1932x1932.
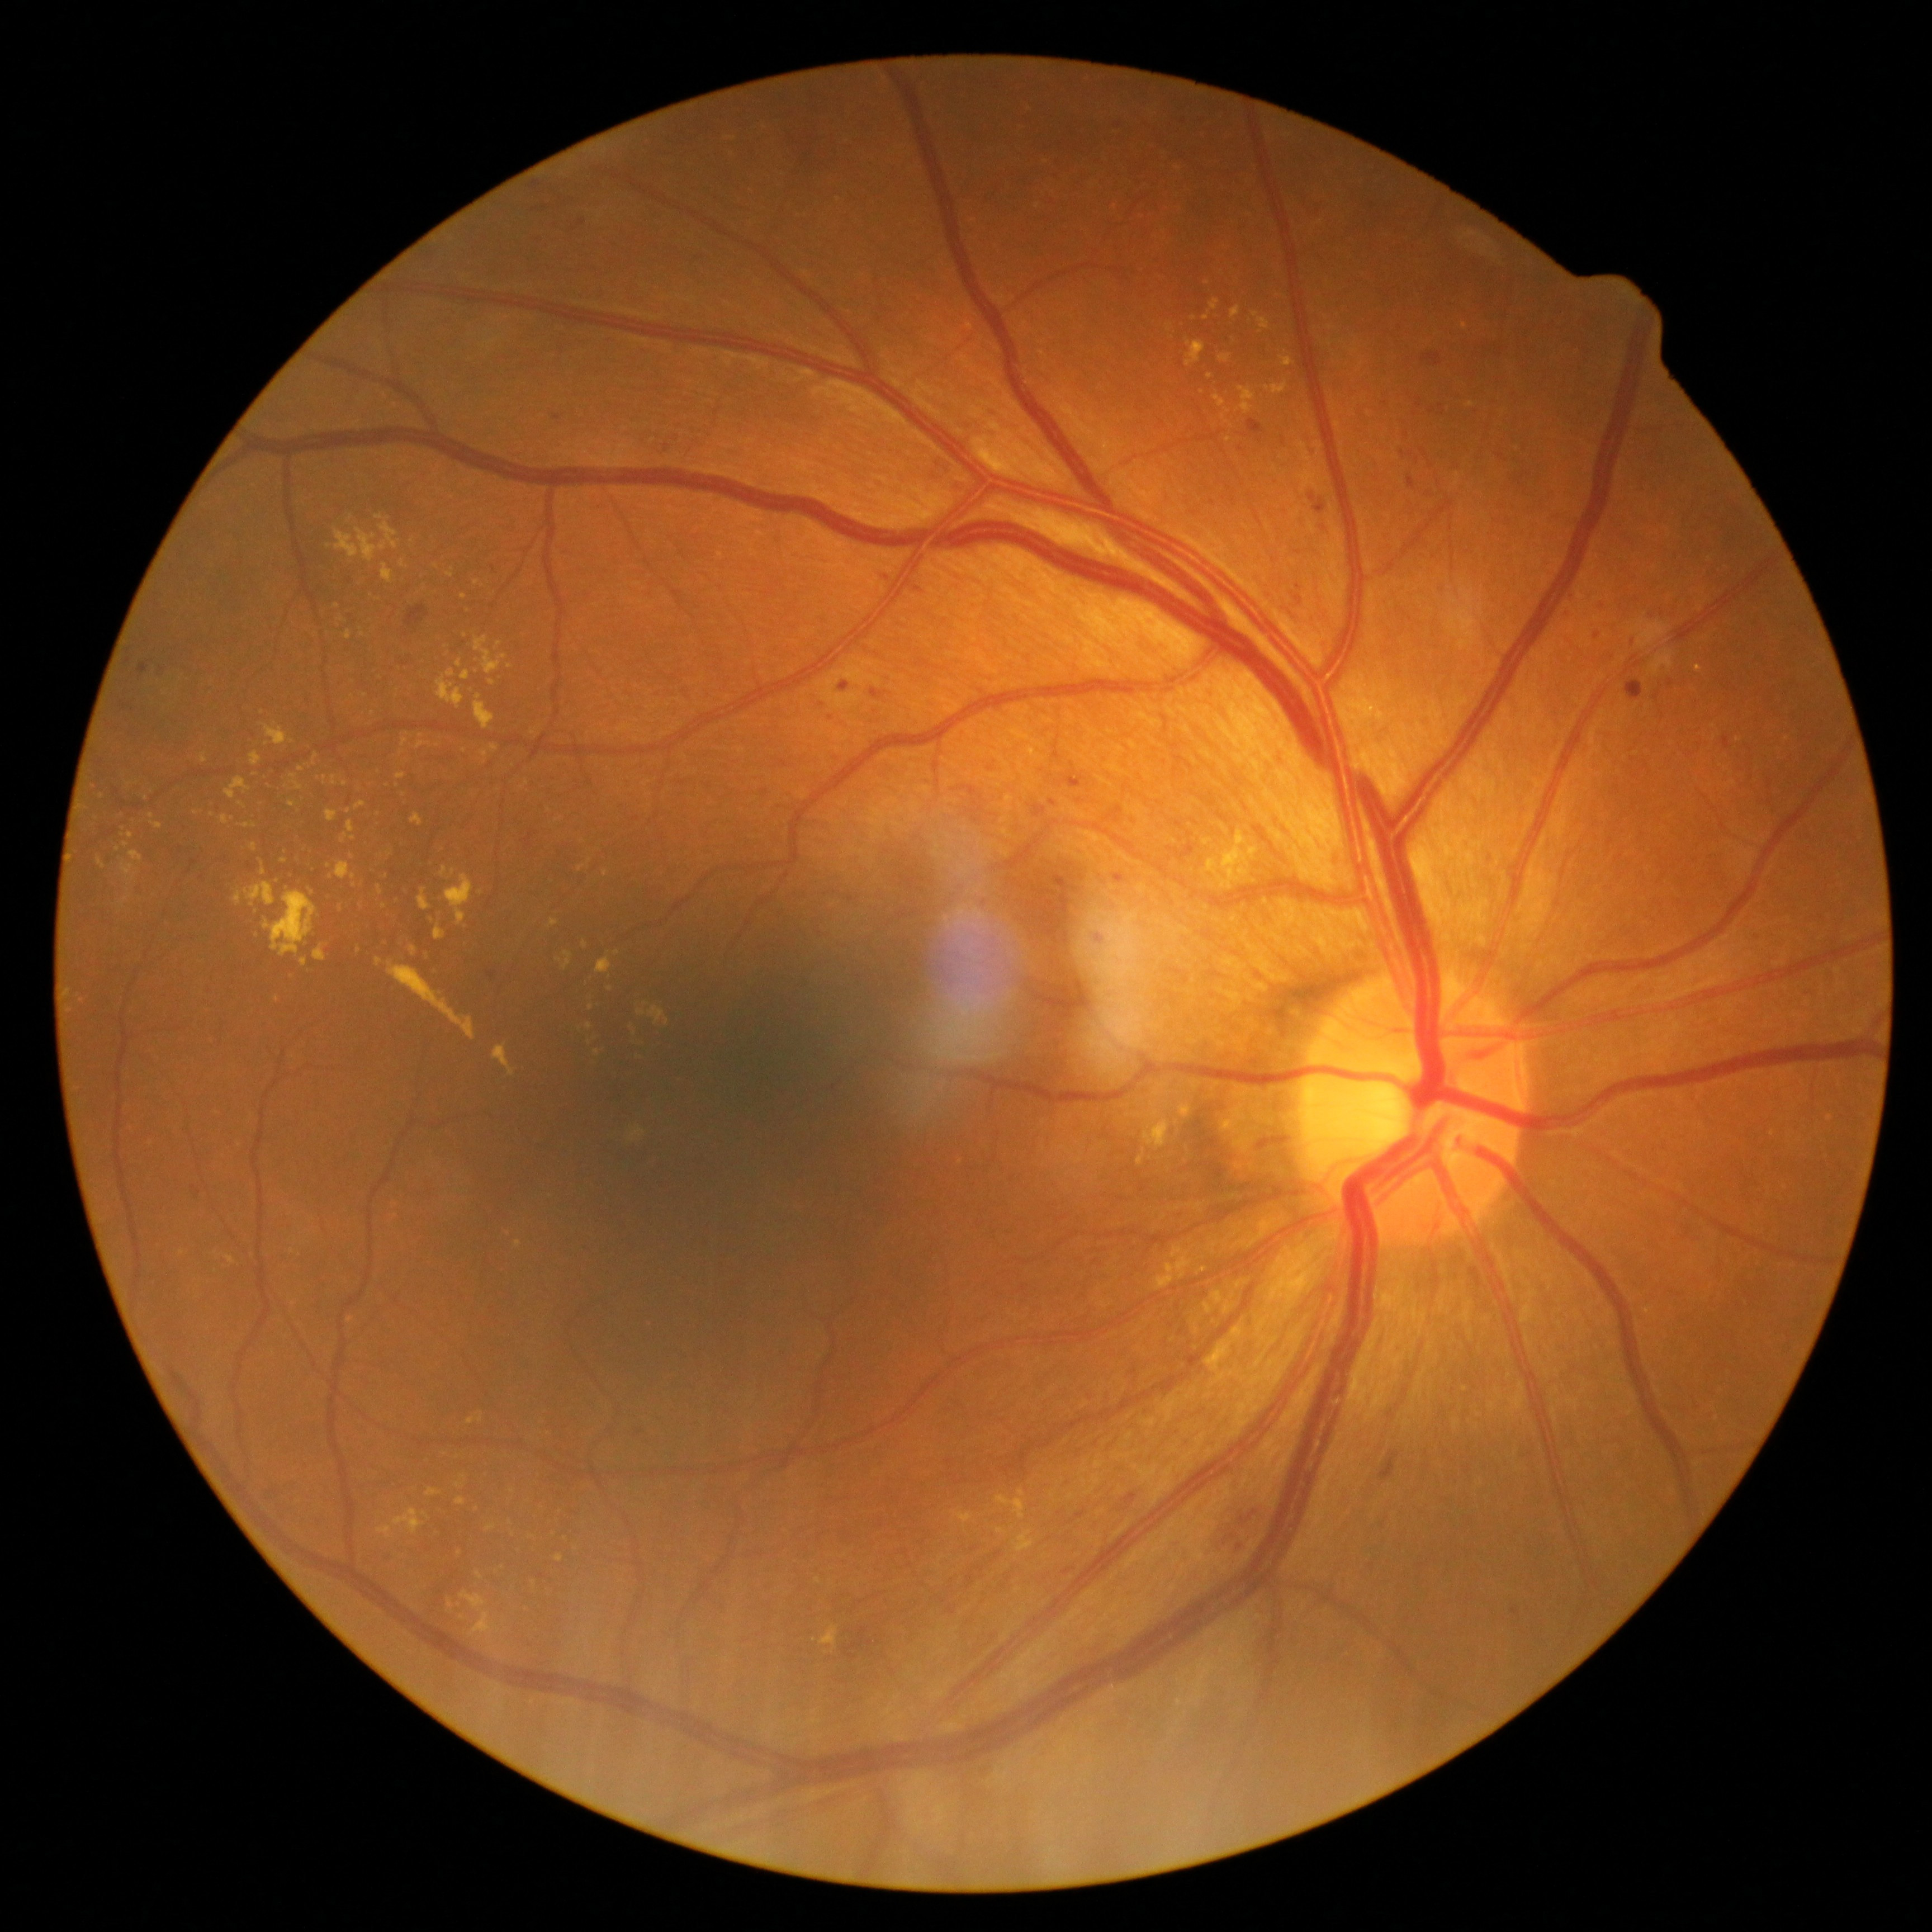

Diabetic retinopathy (DR) is 2
Representative lesions:
hard exudates (EXs) (subset) = box=[448, 1599, 453, 1608] | box=[613, 950, 621, 955] | box=[1252, 312, 1270, 330] | box=[1207, 858, 1219, 875] | box=[468, 1414, 484, 1425] | box=[1696, 666, 1703, 674] | box=[447, 875, 473, 925] | box=[997, 1495, 1026, 1520] | box=[288, 801, 296, 808] | box=[98, 857, 105, 868] | box=[548, 918, 560, 929] | box=[461, 670, 470, 680]
Additional small EXs near {"x": 463, "y": 1477} | {"x": 1206, "y": 318} | {"x": 316, "y": 757} | {"x": 642, "y": 731} | {"x": 513, "y": 1533} | {"x": 152, "y": 816} | {"x": 277, "y": 999}